Retinal fundus photograph, image size 2352x1568.
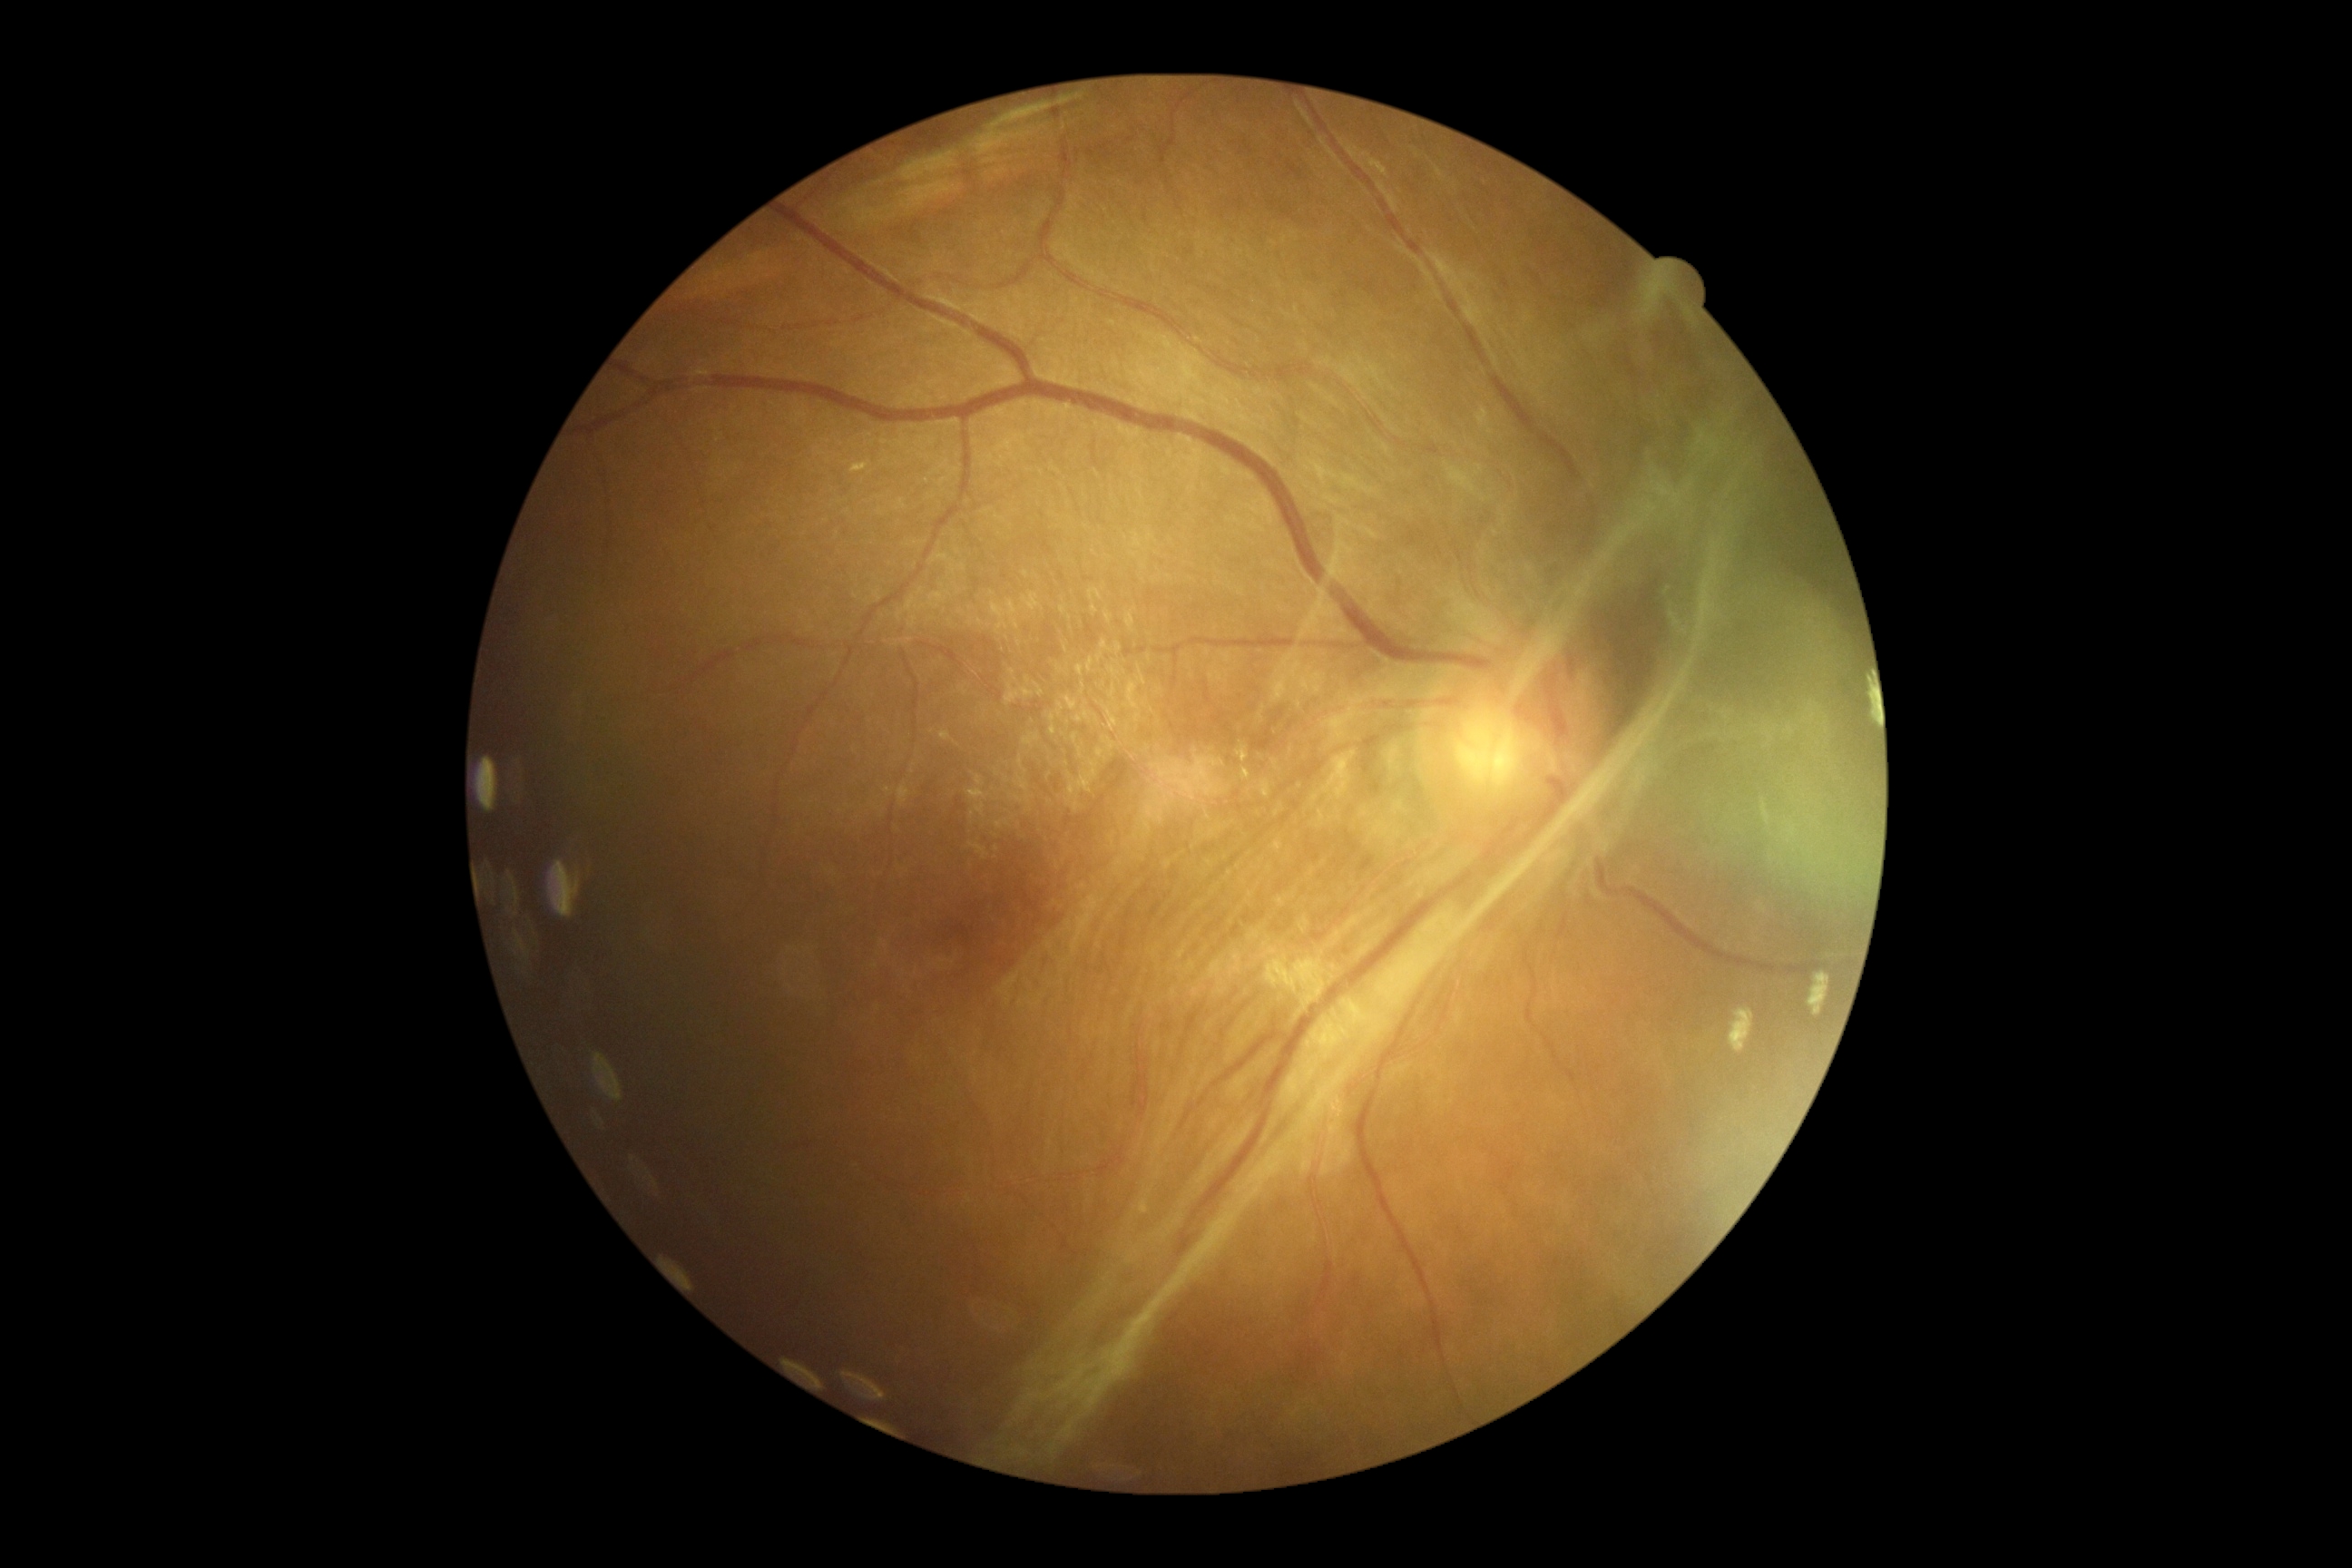

DR grade: PDR (4) — neovascularization and/or vitreous/pre-retinal hemorrhage.